1932 x 1932 pixels — 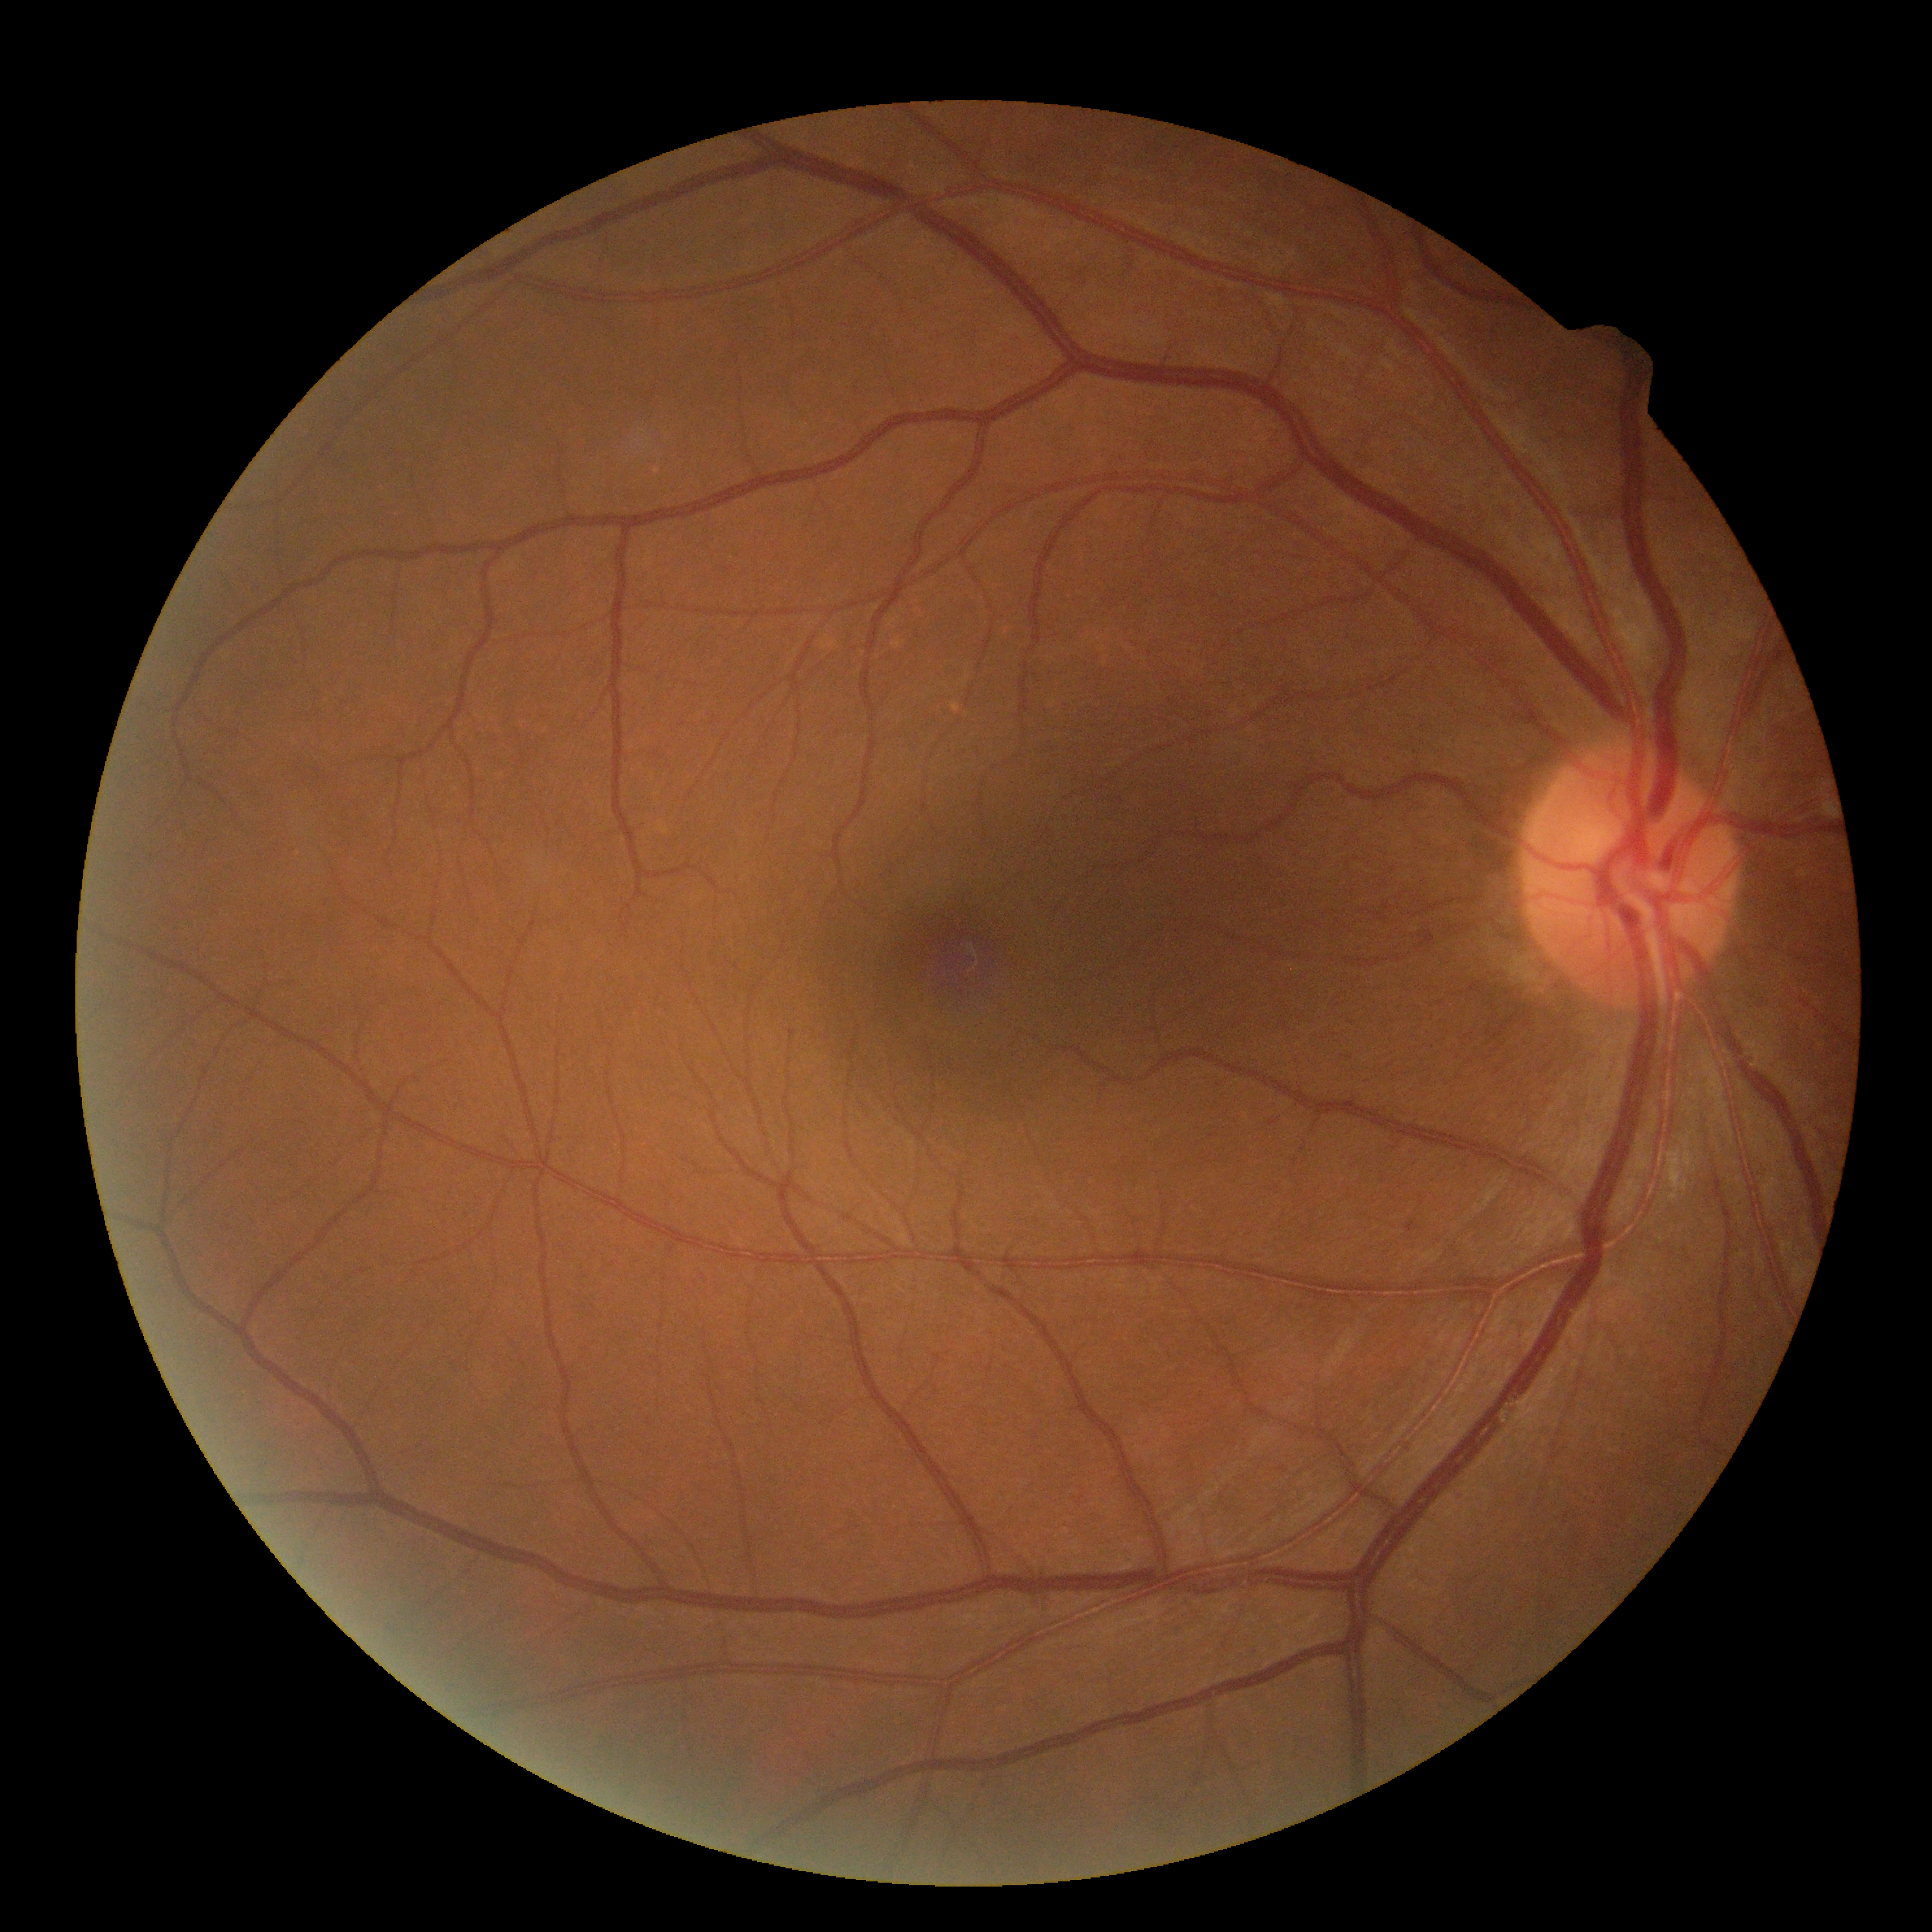
Retinopathy: grade 0 — no visible signs of diabetic retinopathy.